848x848px: 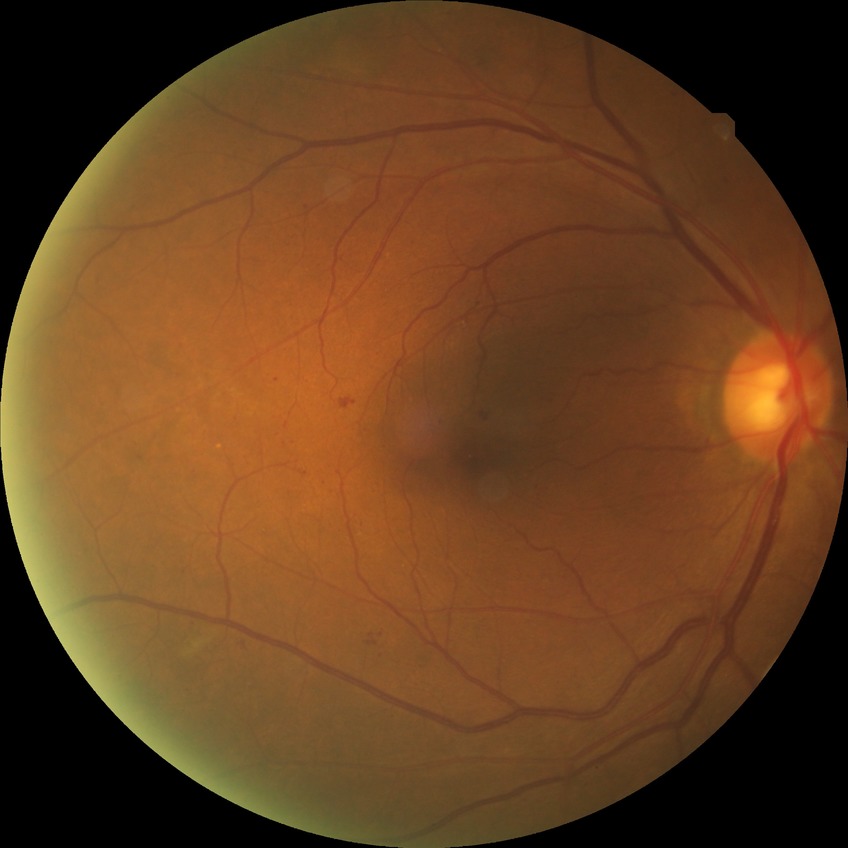 diabetic retinopathy severity = simple diabetic retinopathy